1932x1932.
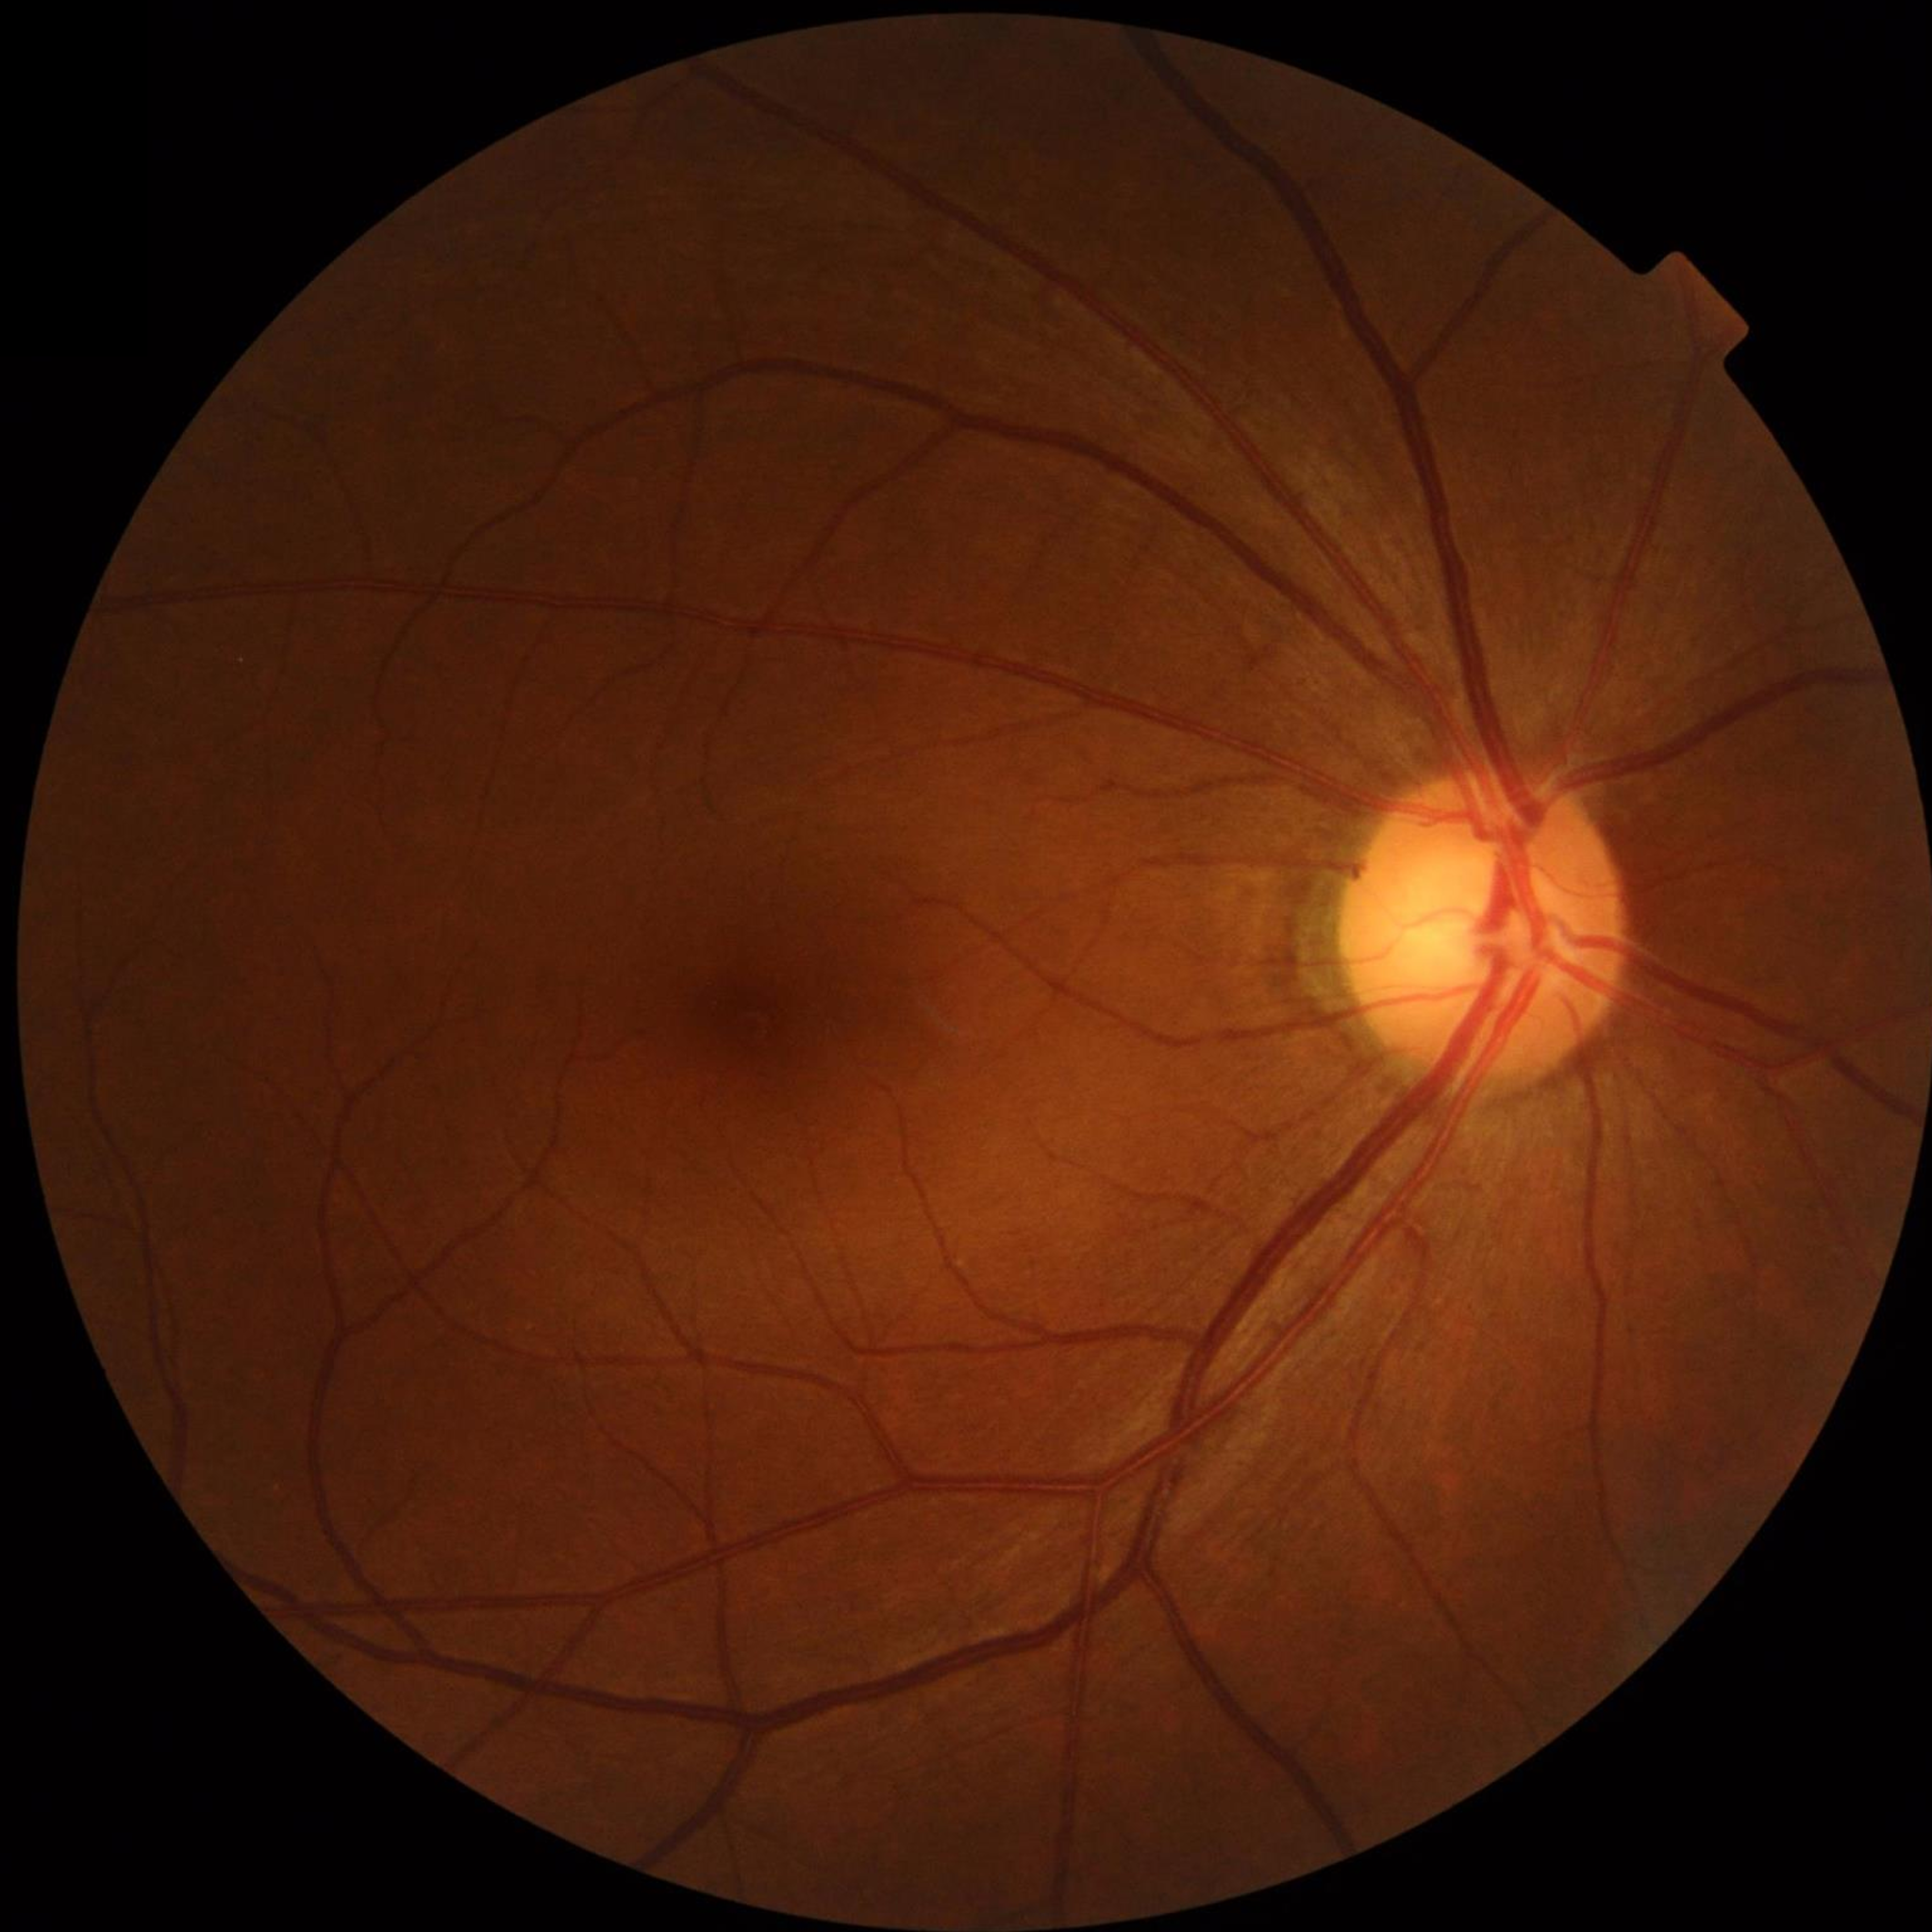 Impression: no AMD, DR, or glaucomatous findings.